Image size 640x480 · 130° field of view (Clarity RetCam 3) · wide-field fundus photograph of an infant: 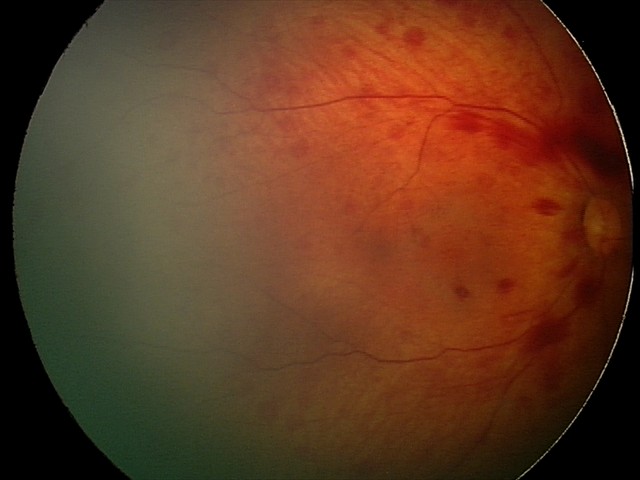

Series diagnosed as retinal hemorrhages.